Image size 848x848. 45-degree field of view.
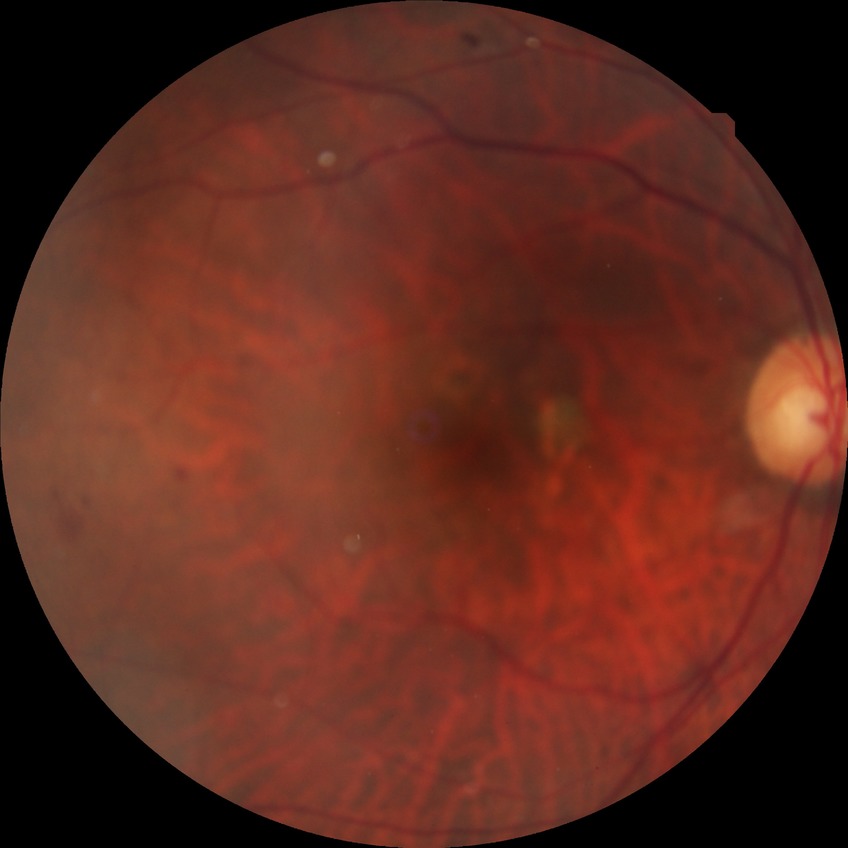 • modified Davis grade — NDR
• DR impression — no DR findings